512x512: 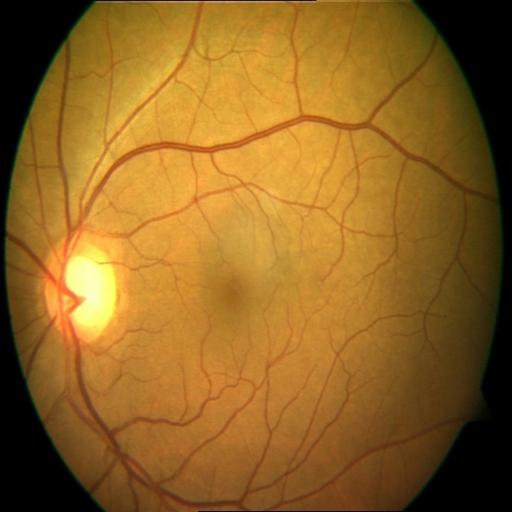 Diagnoses (2): central serous retinopathy, optic disc cupping.